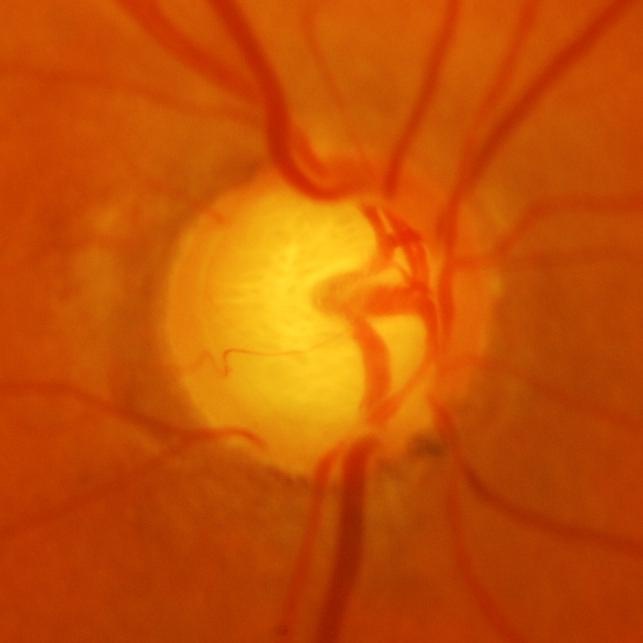 Glaucomatous optic neuropathy is present. Demonstrates glaucoma.